Nonmydriatic fundus photograph, 45 degree fundus photograph, 848 x 848 pixels.
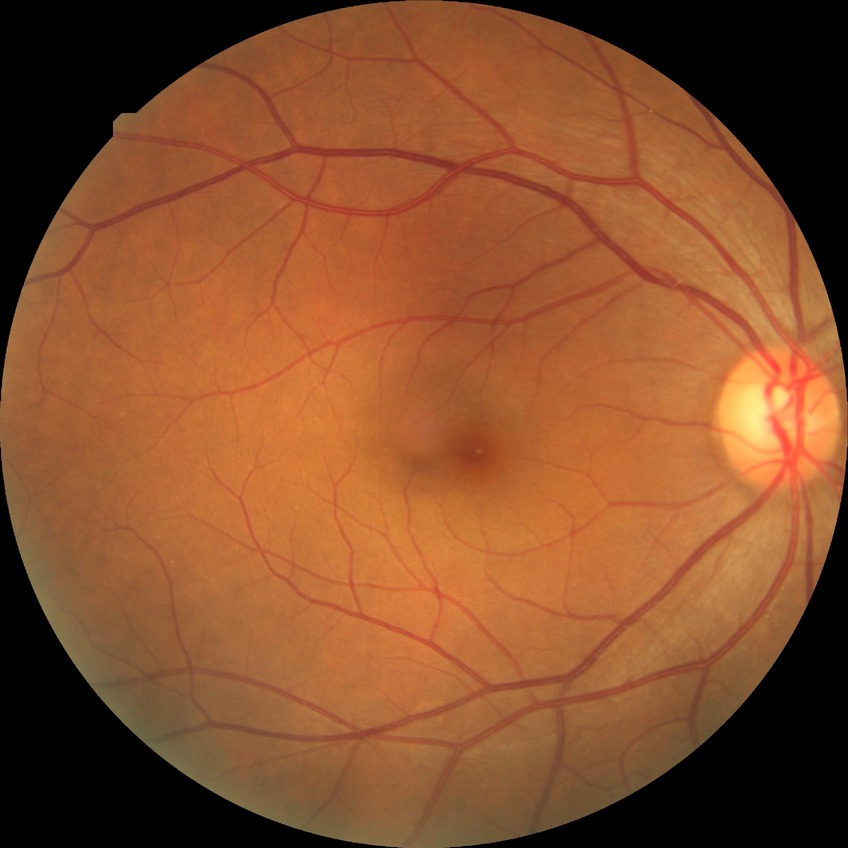
Diabetic retinopathy (DR) is no diabetic retinopathy (NDR).